2184x1690px
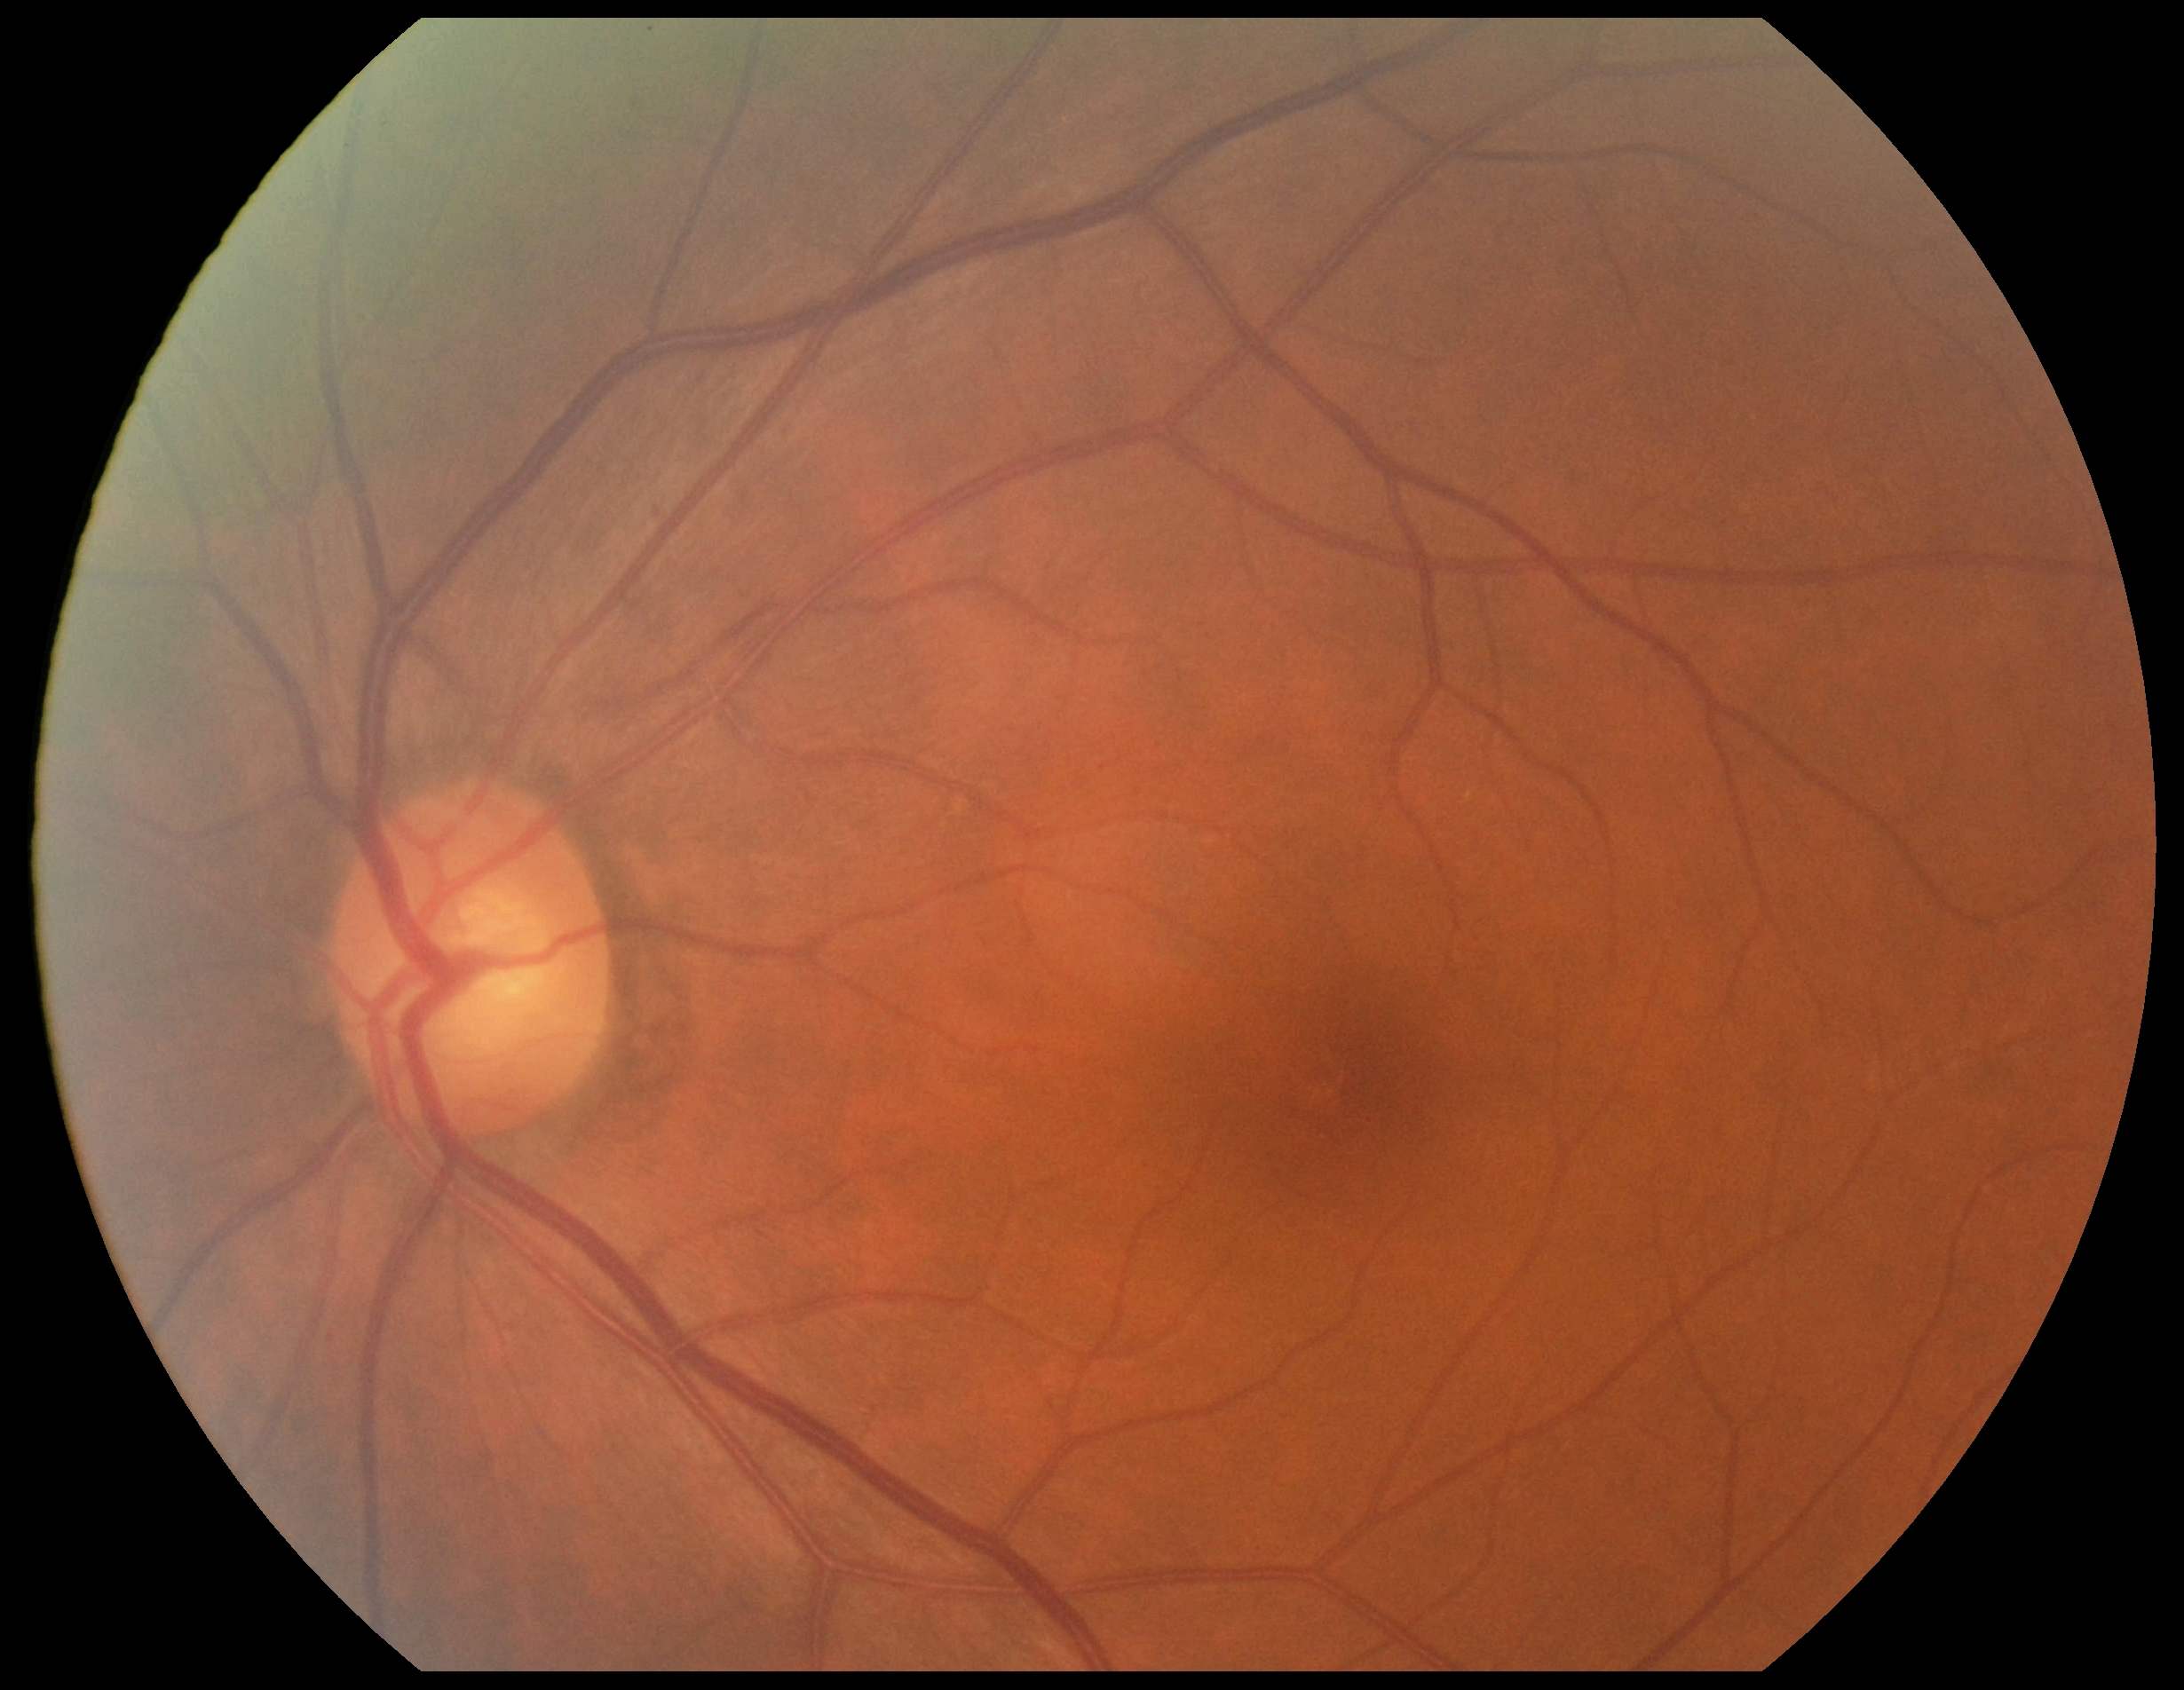

Annotations:
* retinopathy — no apparent diabetic retinopathy (grade 0)